848 by 848 pixels. CFP. Nonmydriatic fundus photograph.
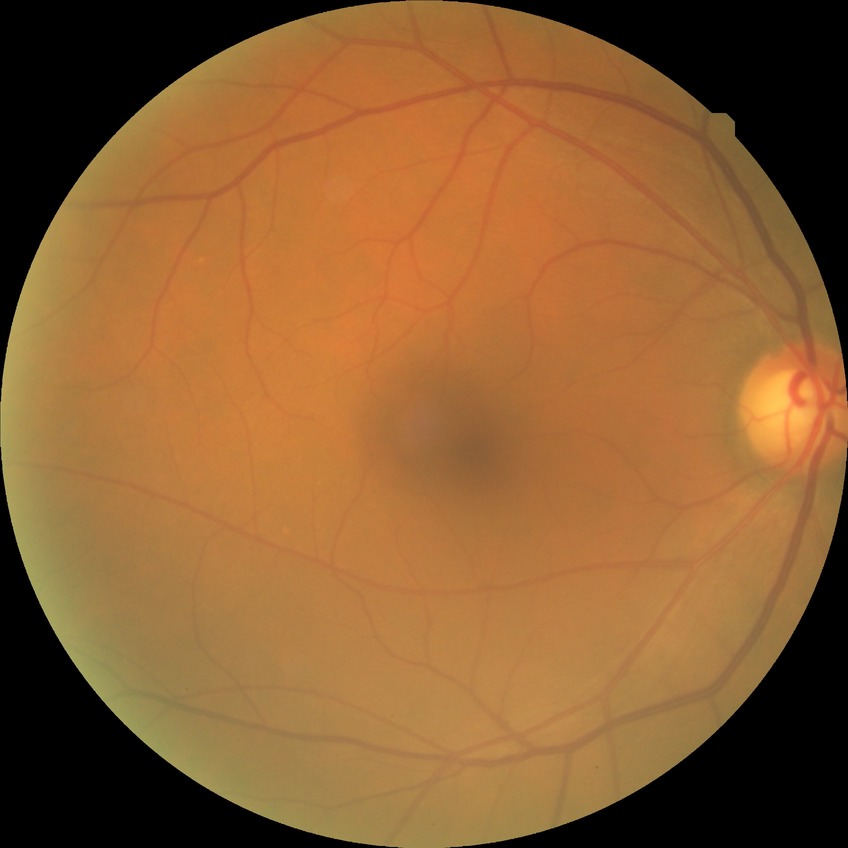
diabetic retinopathy (DR) = NDR (no diabetic retinopathy).